Retinal fundus photograph; 1659x2212px:
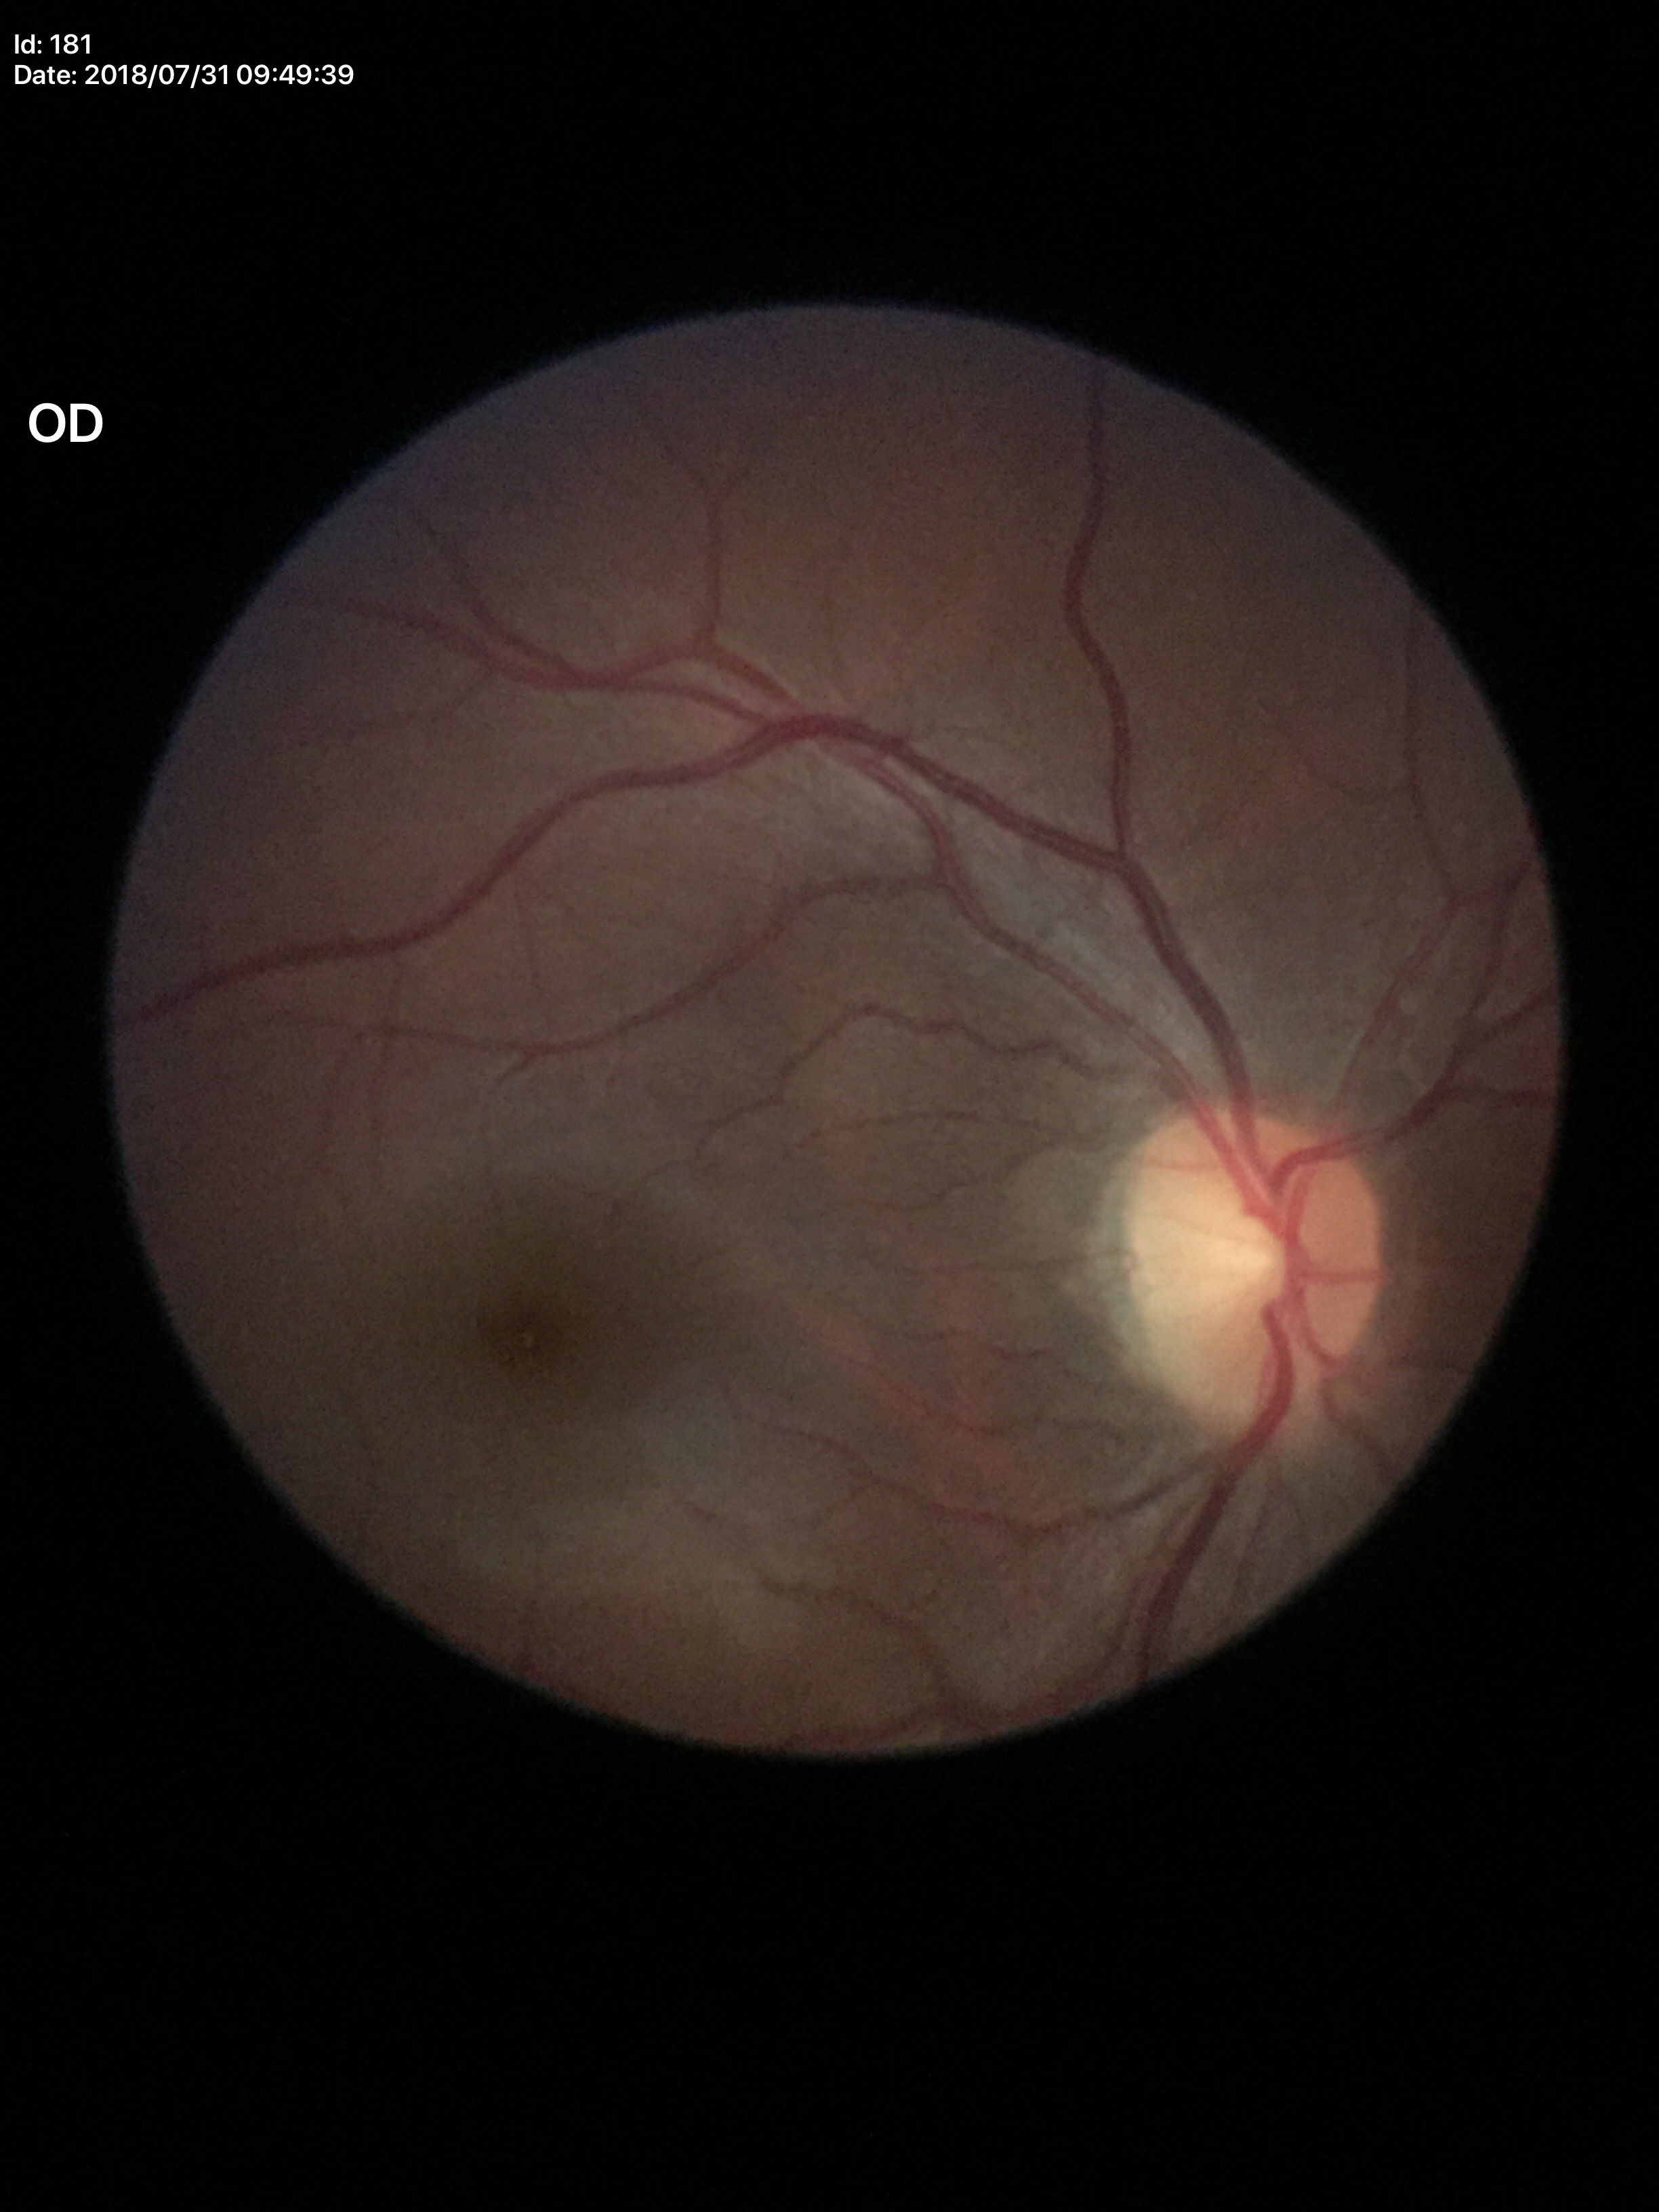

HCDR: 0.48.
VCDR: 0.44.
Not suspicious for glaucoma.